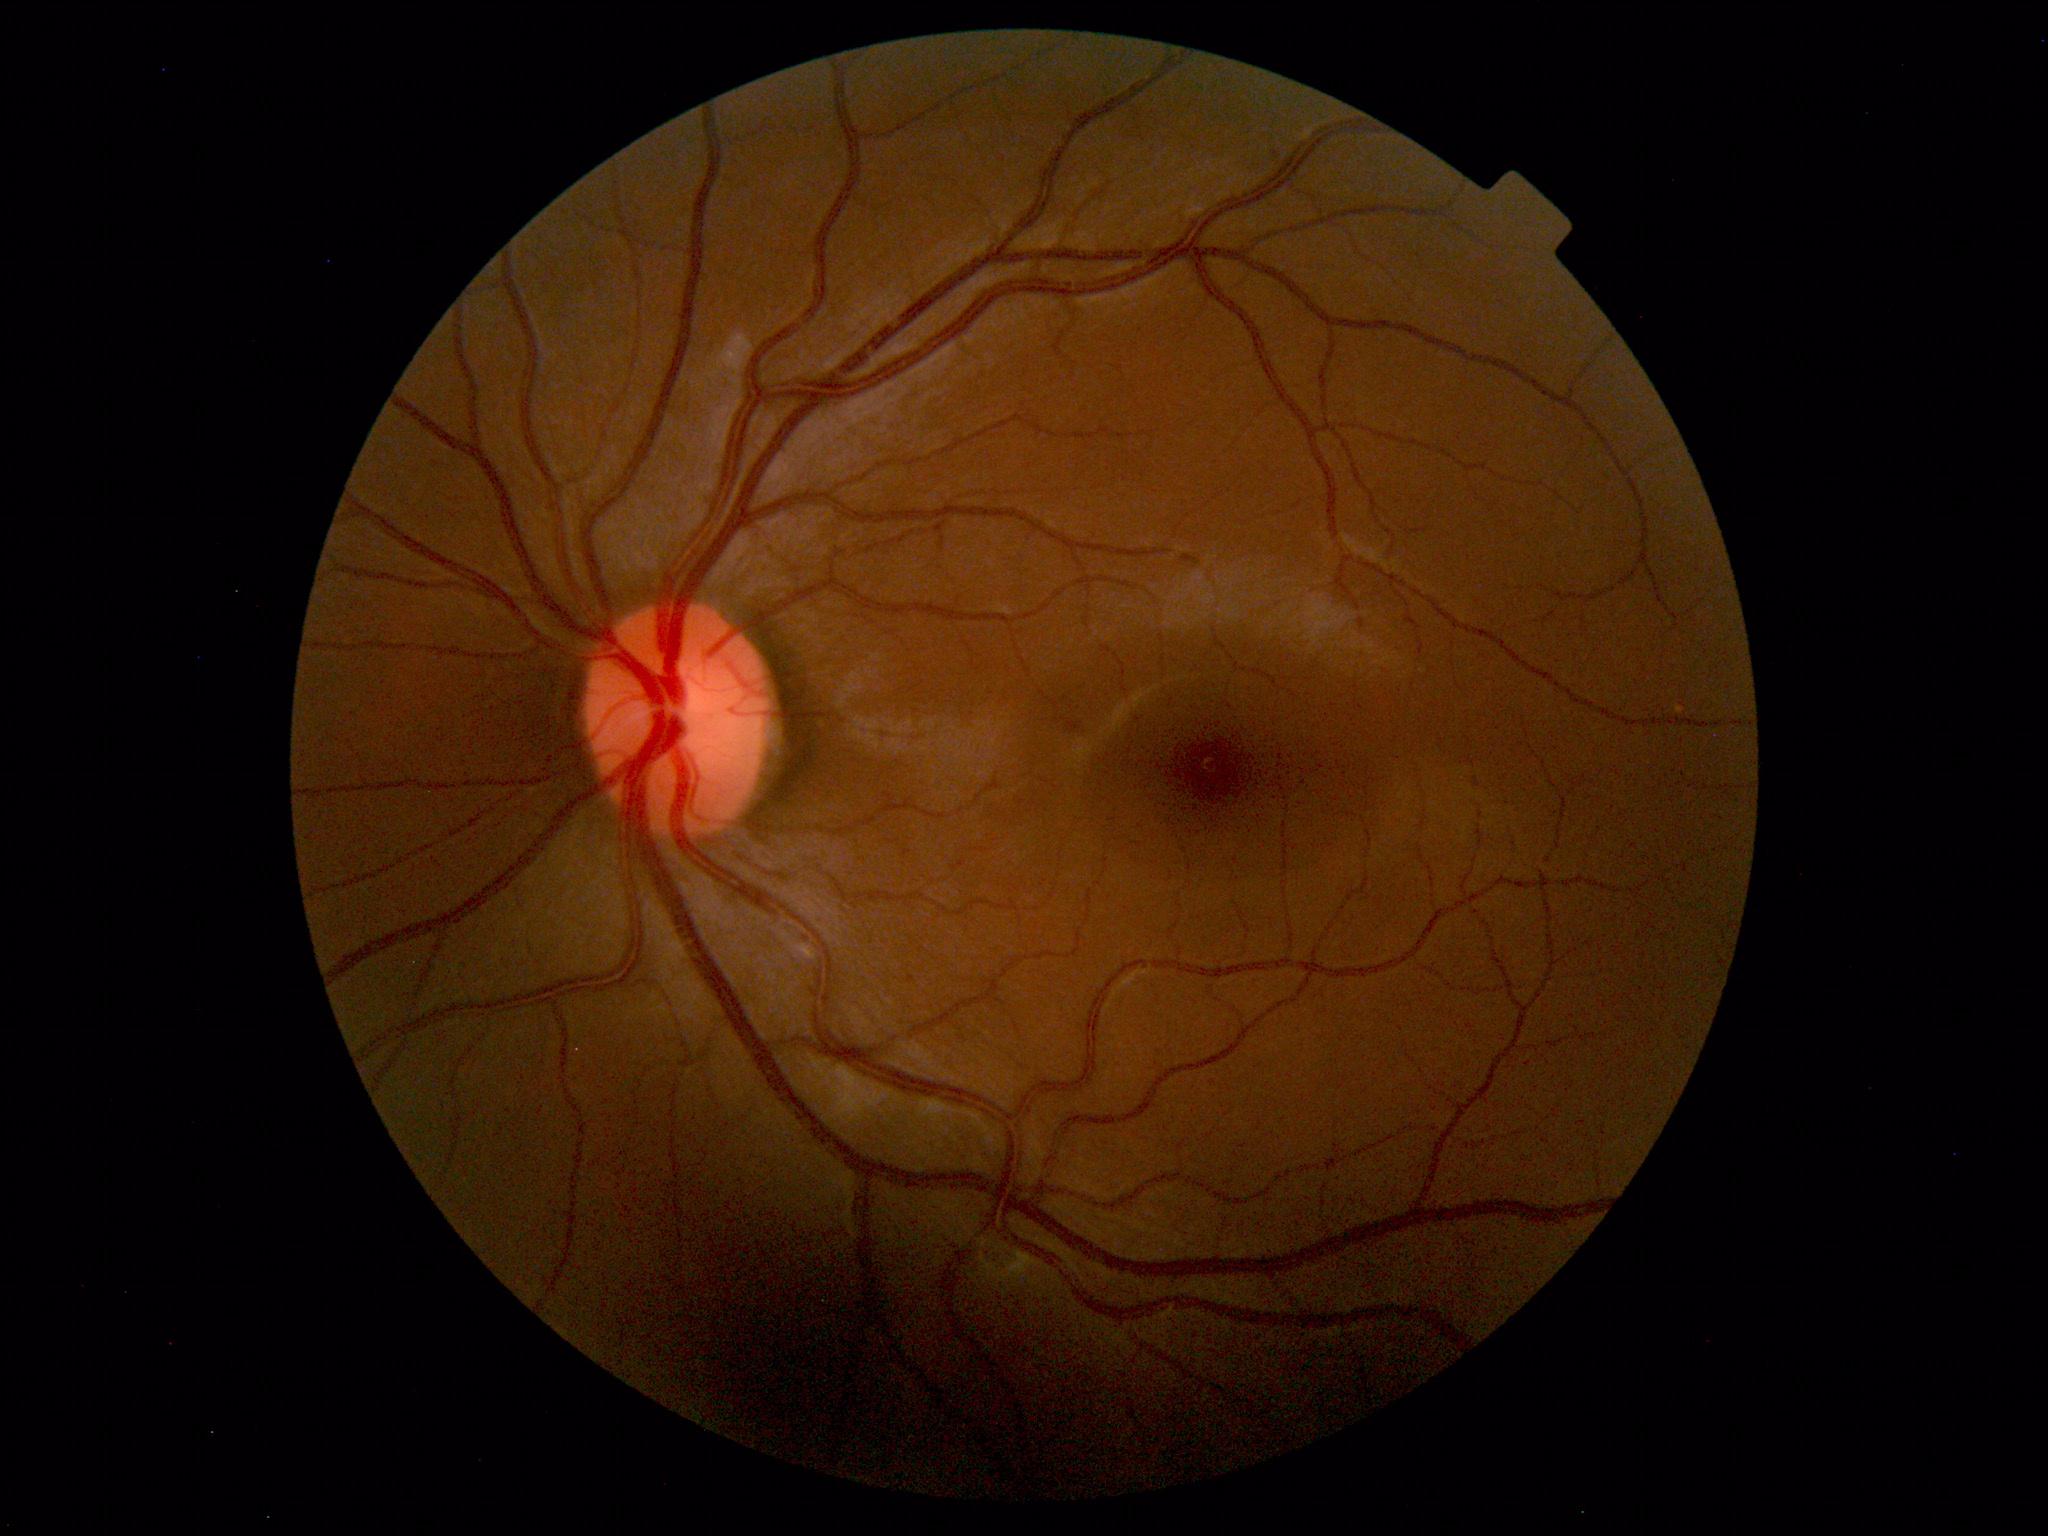
Within normal limits. No abnormalities identified.